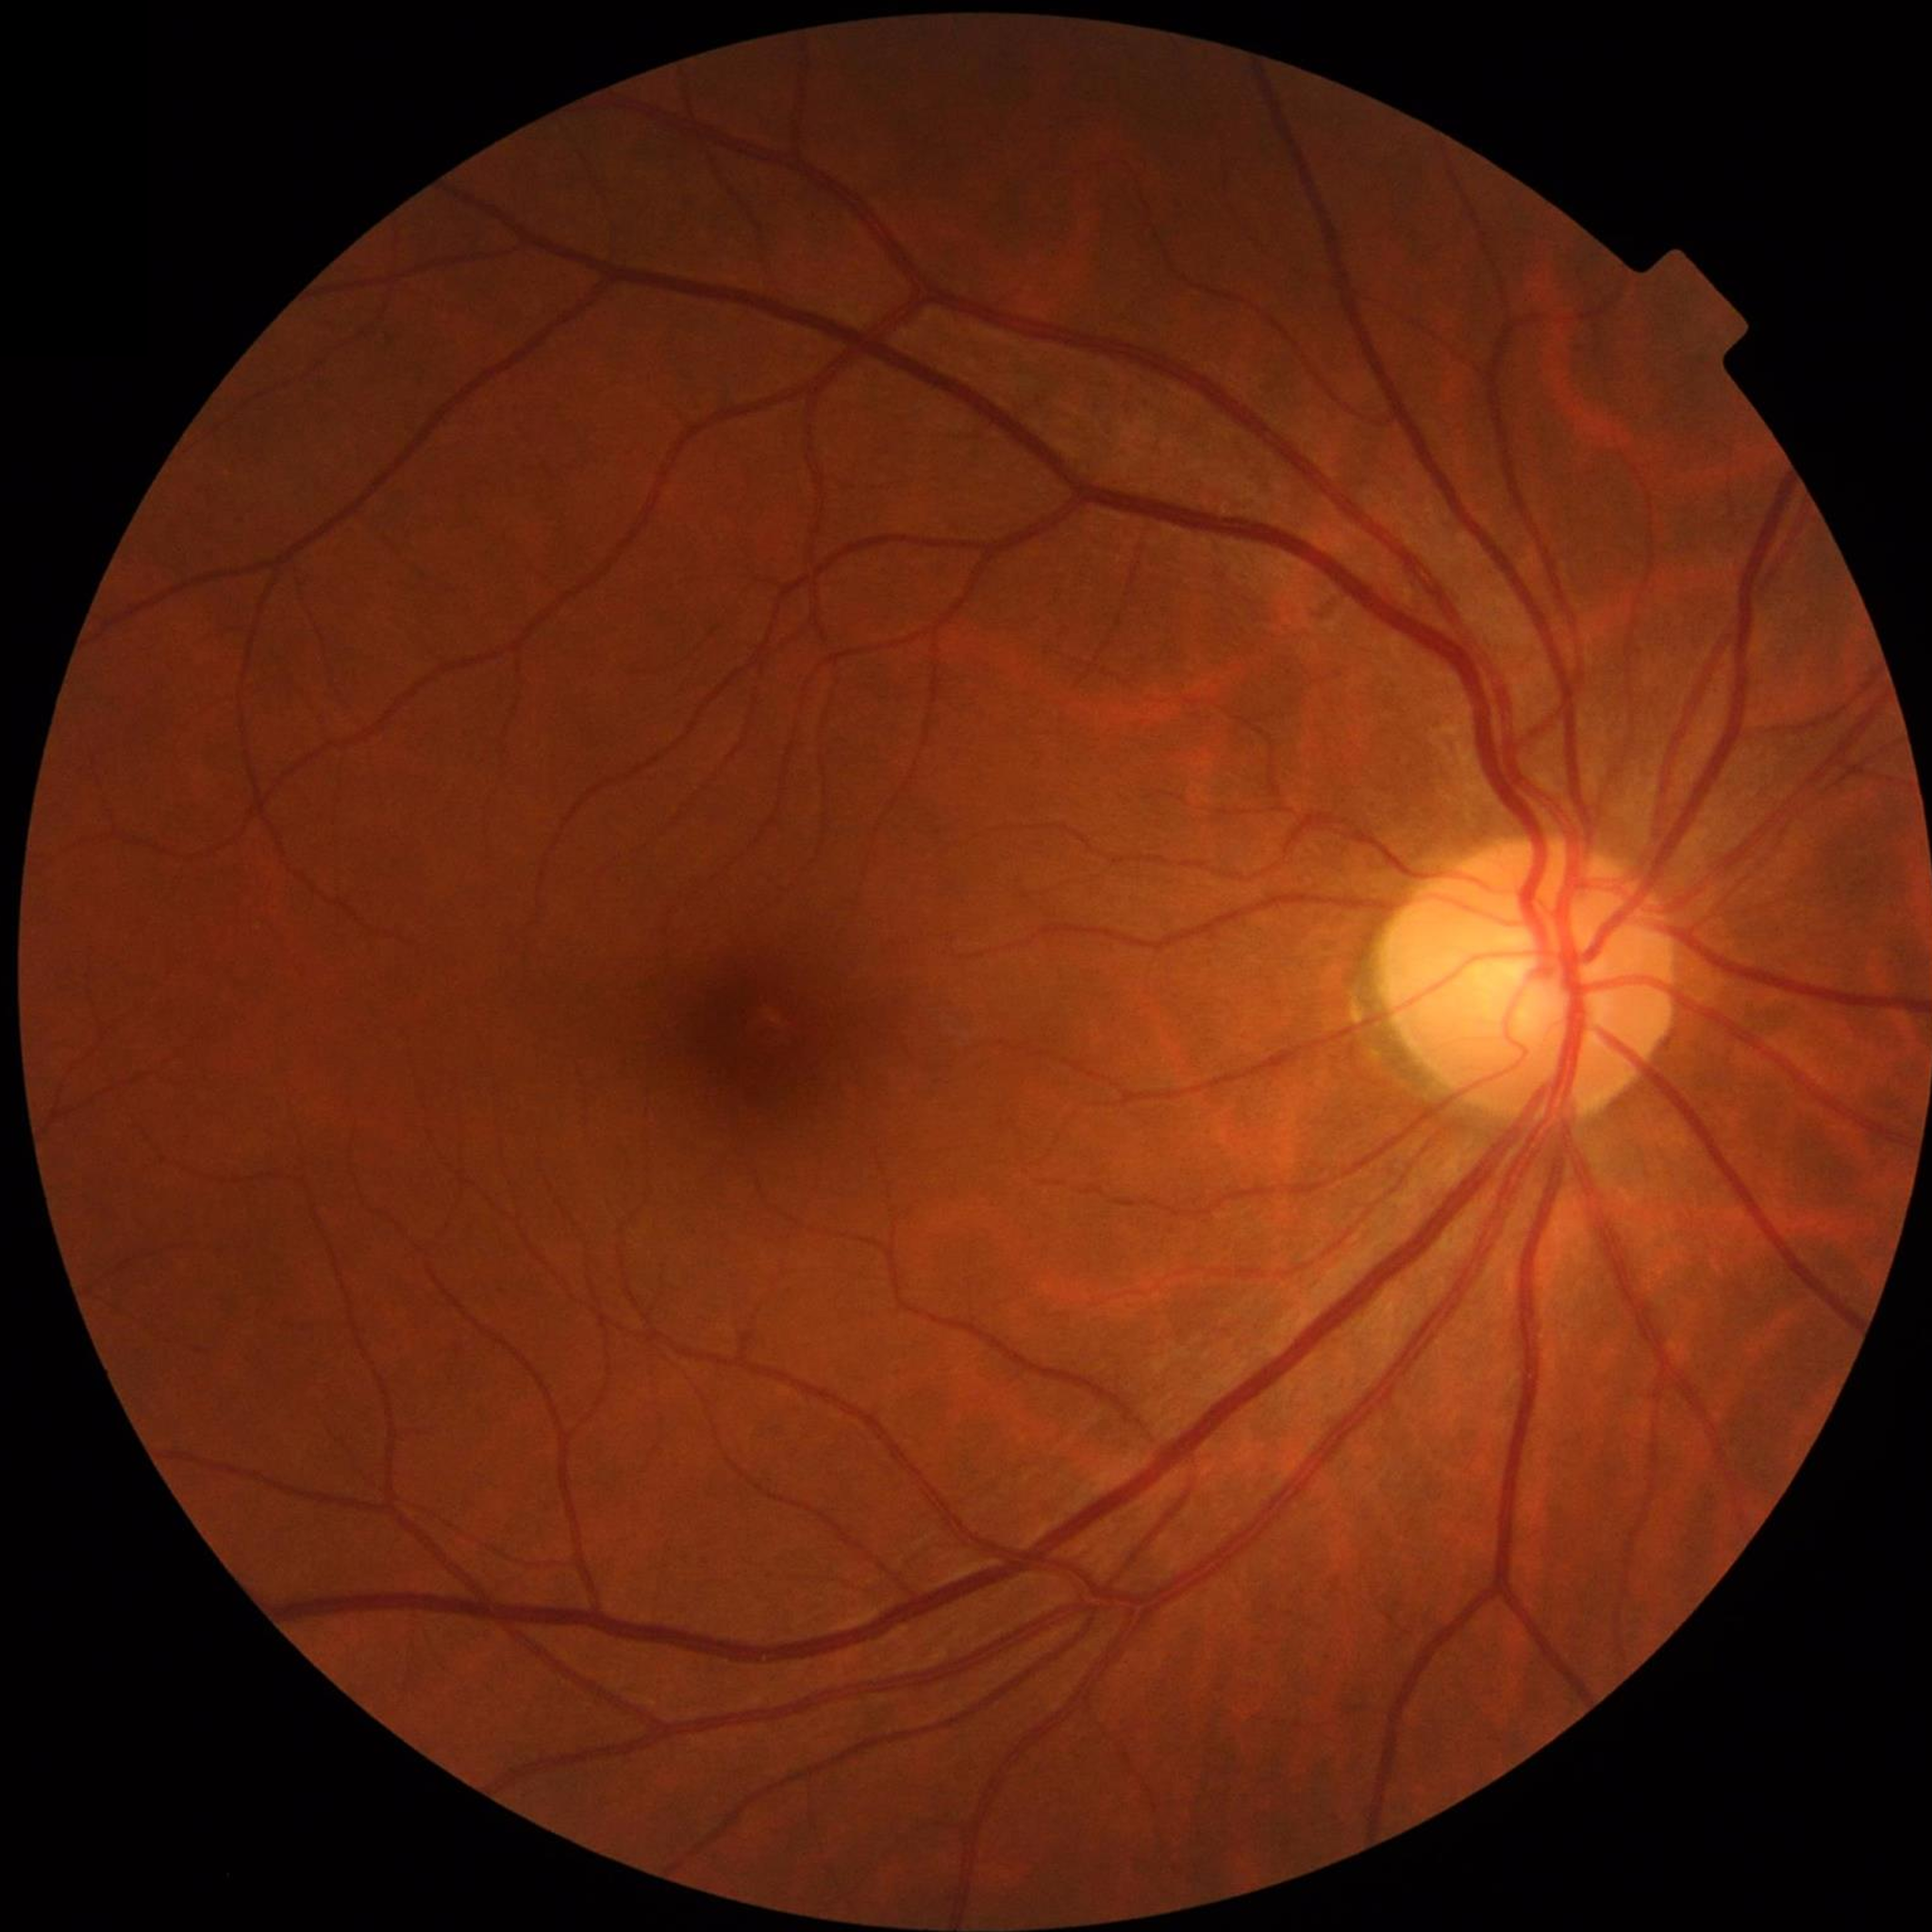 {
  "image_quality": "no quality issues identified",
  "diagnosis": "no AMD, DR, or glaucomatous findings"
}